Color fundus image: 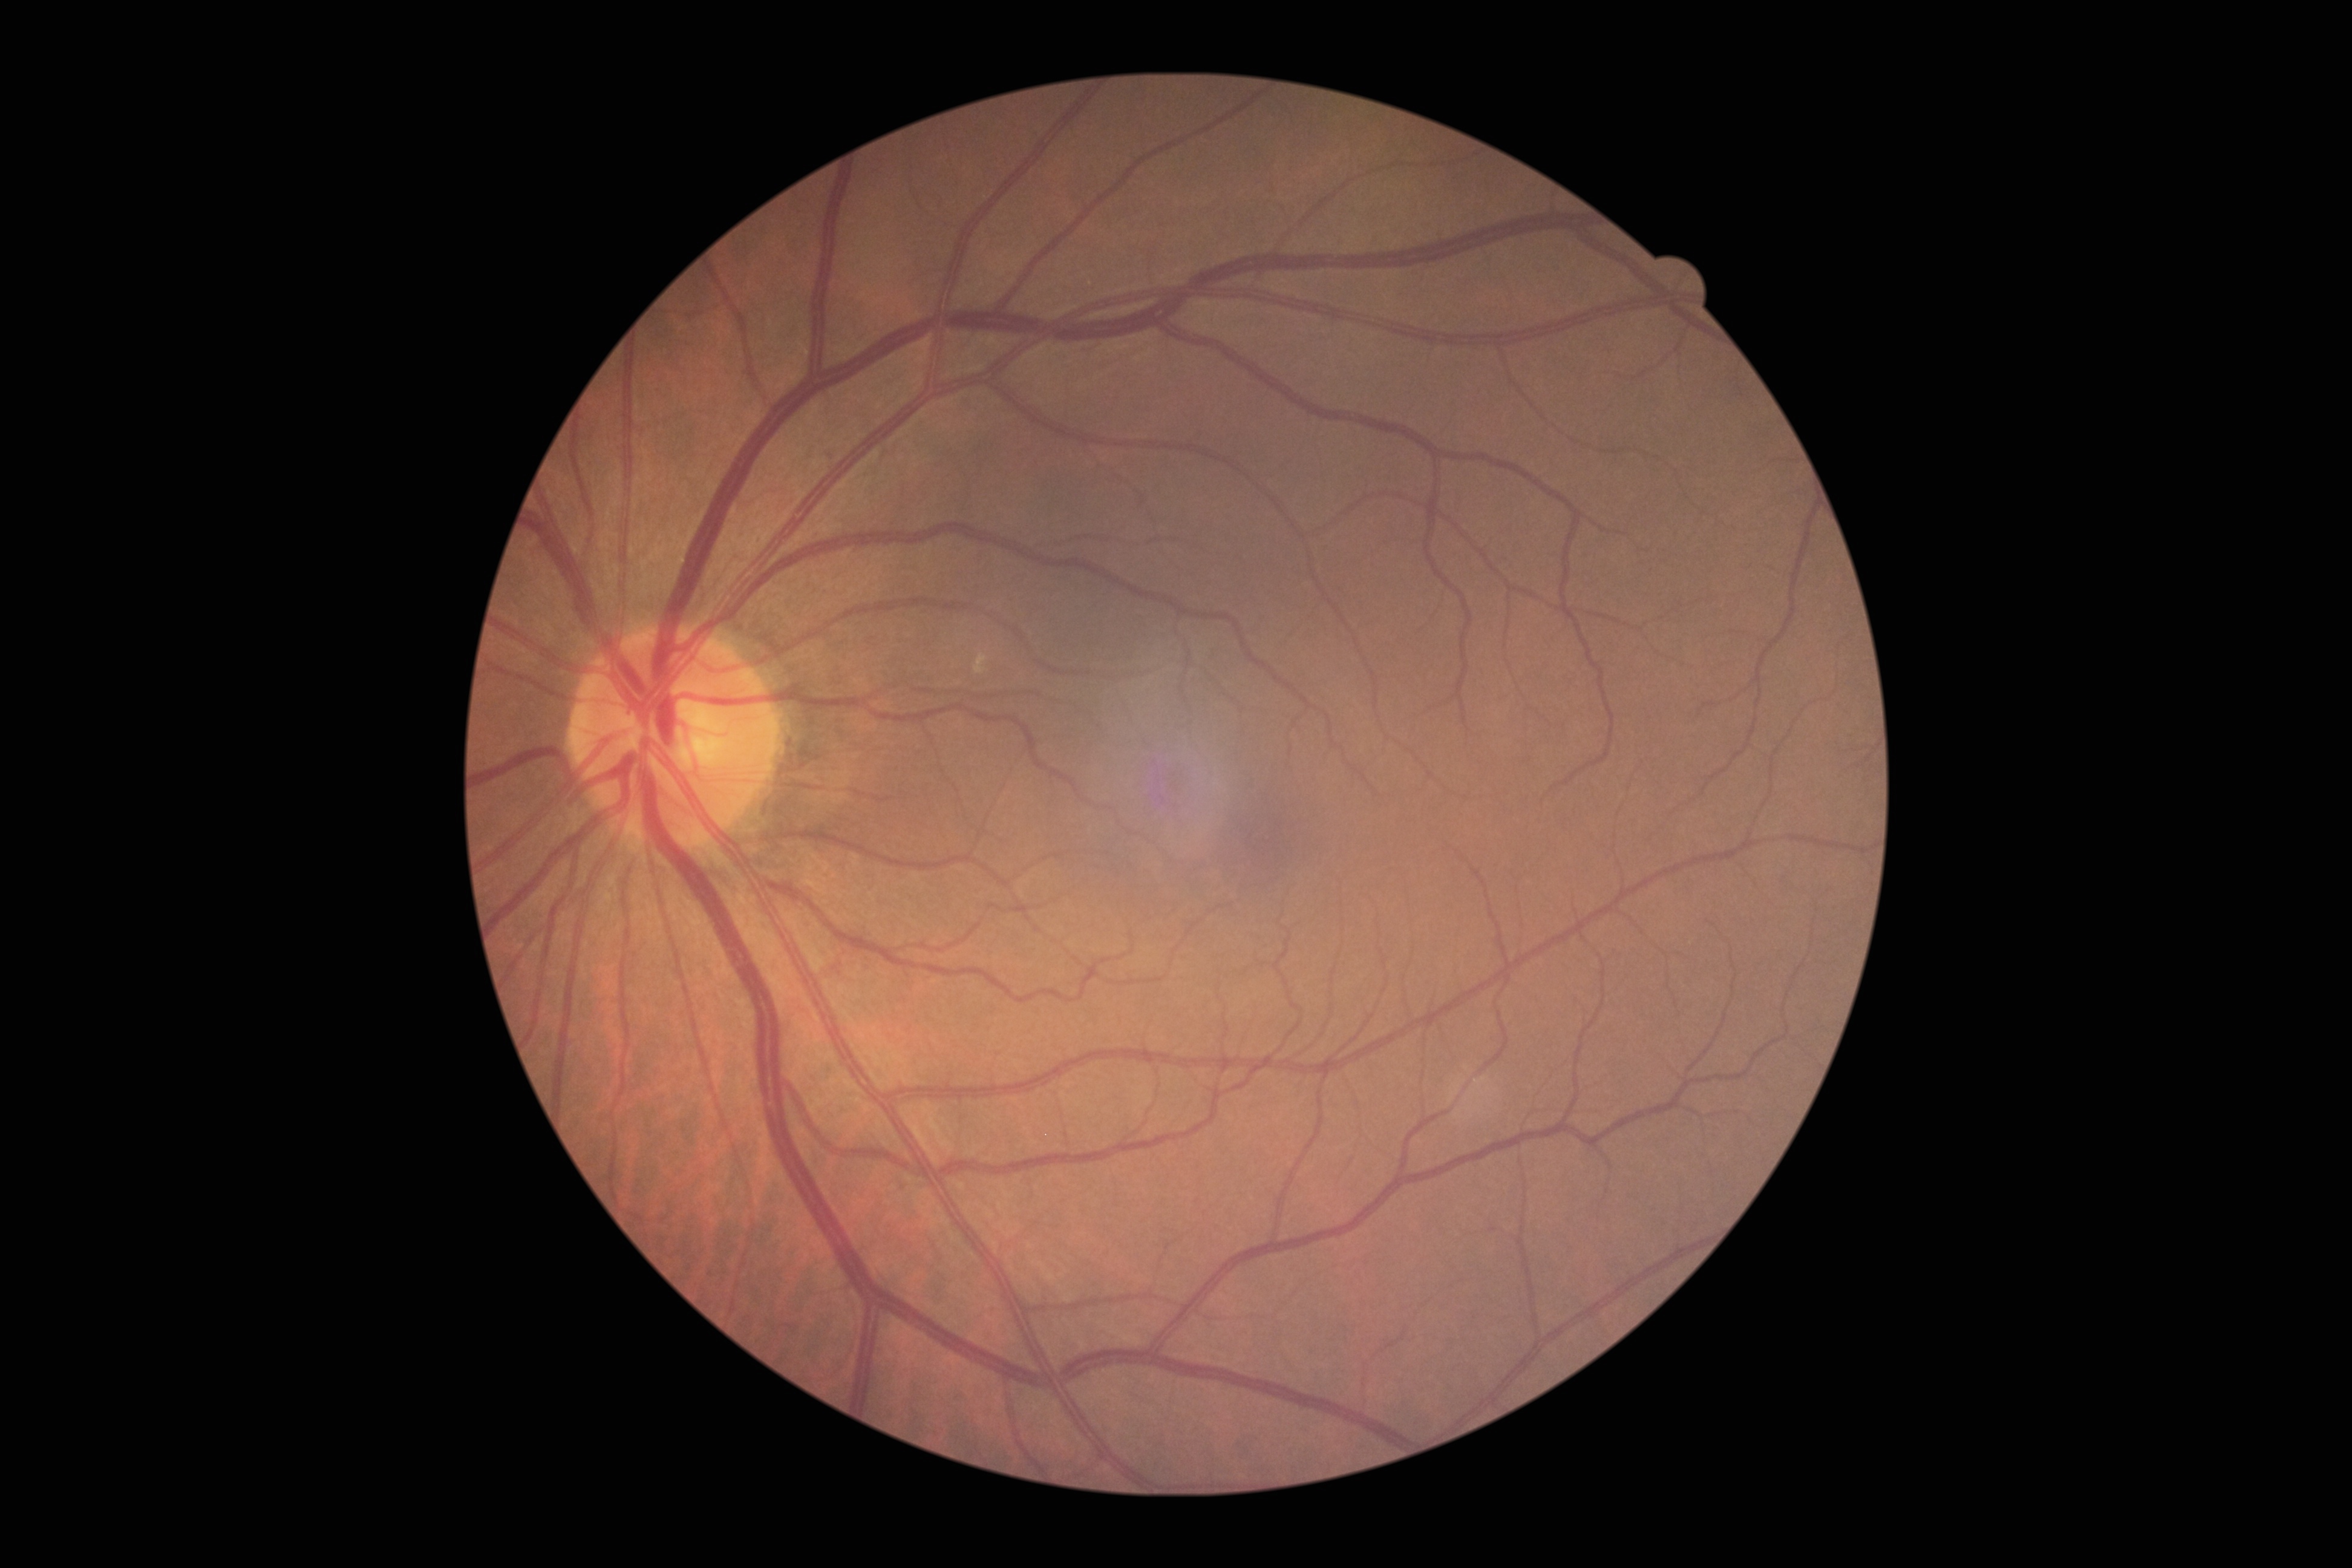

No signs of diabetic retinopathy. Retinopathy: 0.